Color fundus photograph:
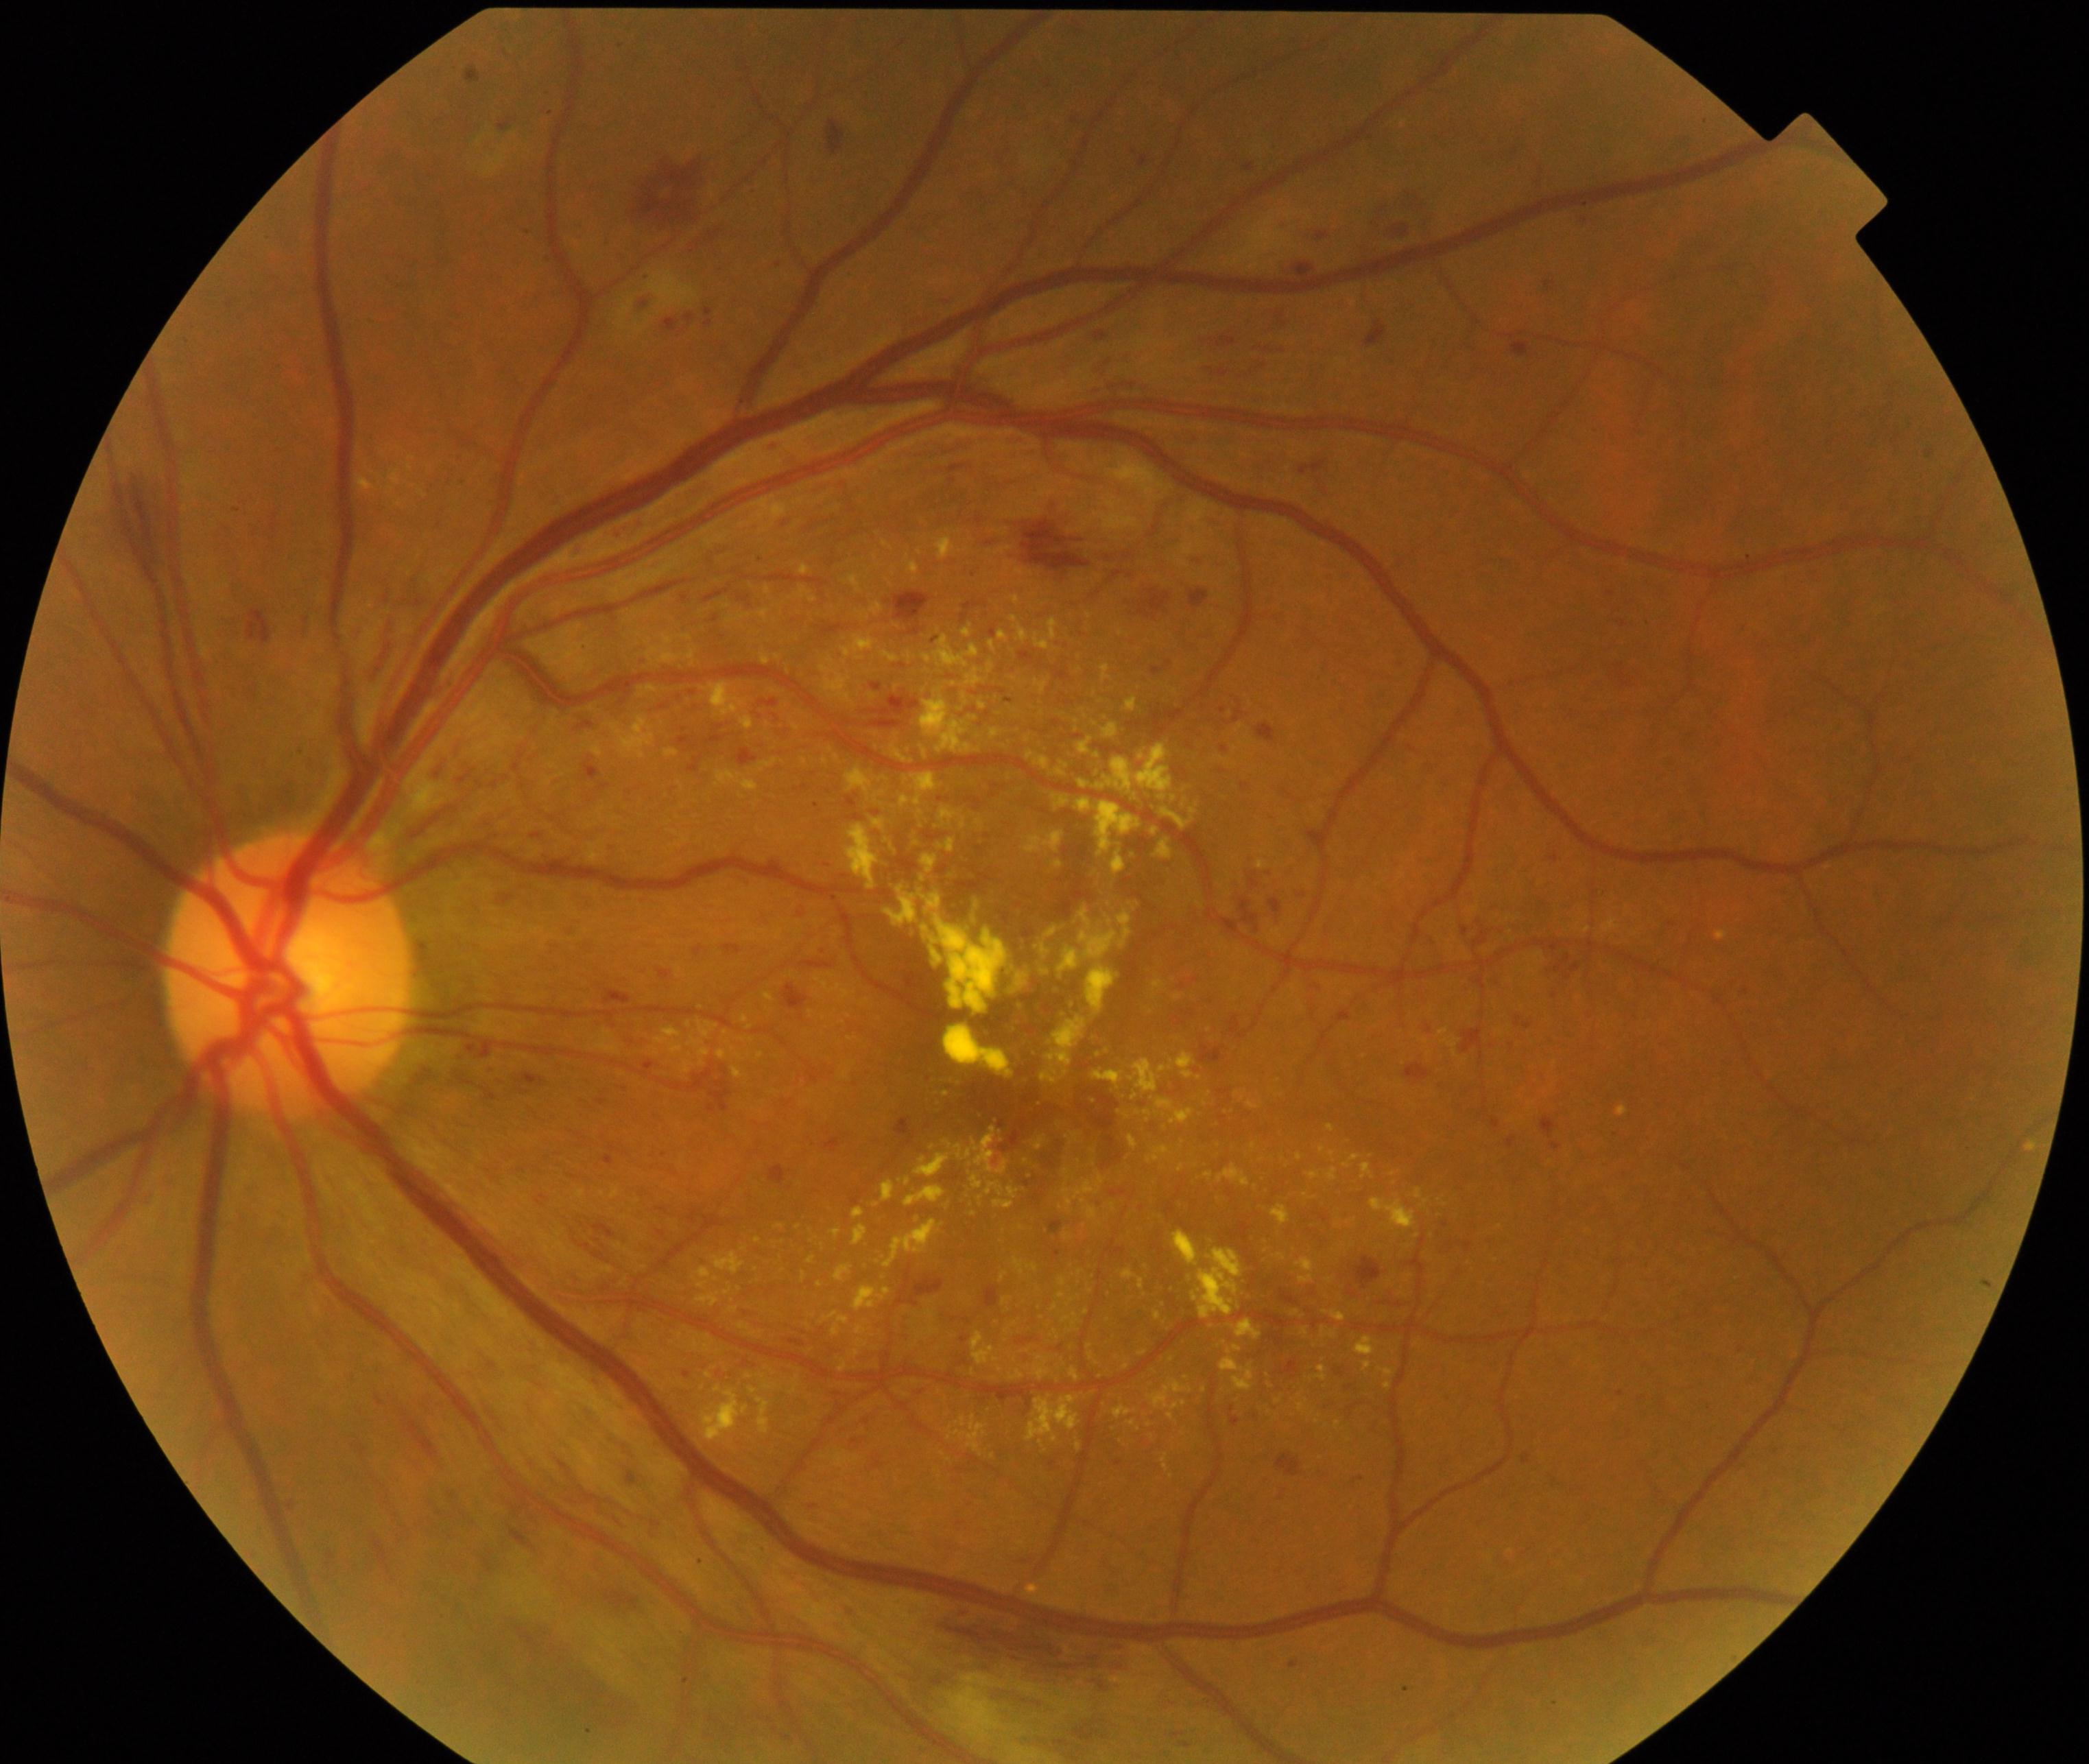 The image shows moderate non-proliferative diabetic retinopathy.